45° FOV
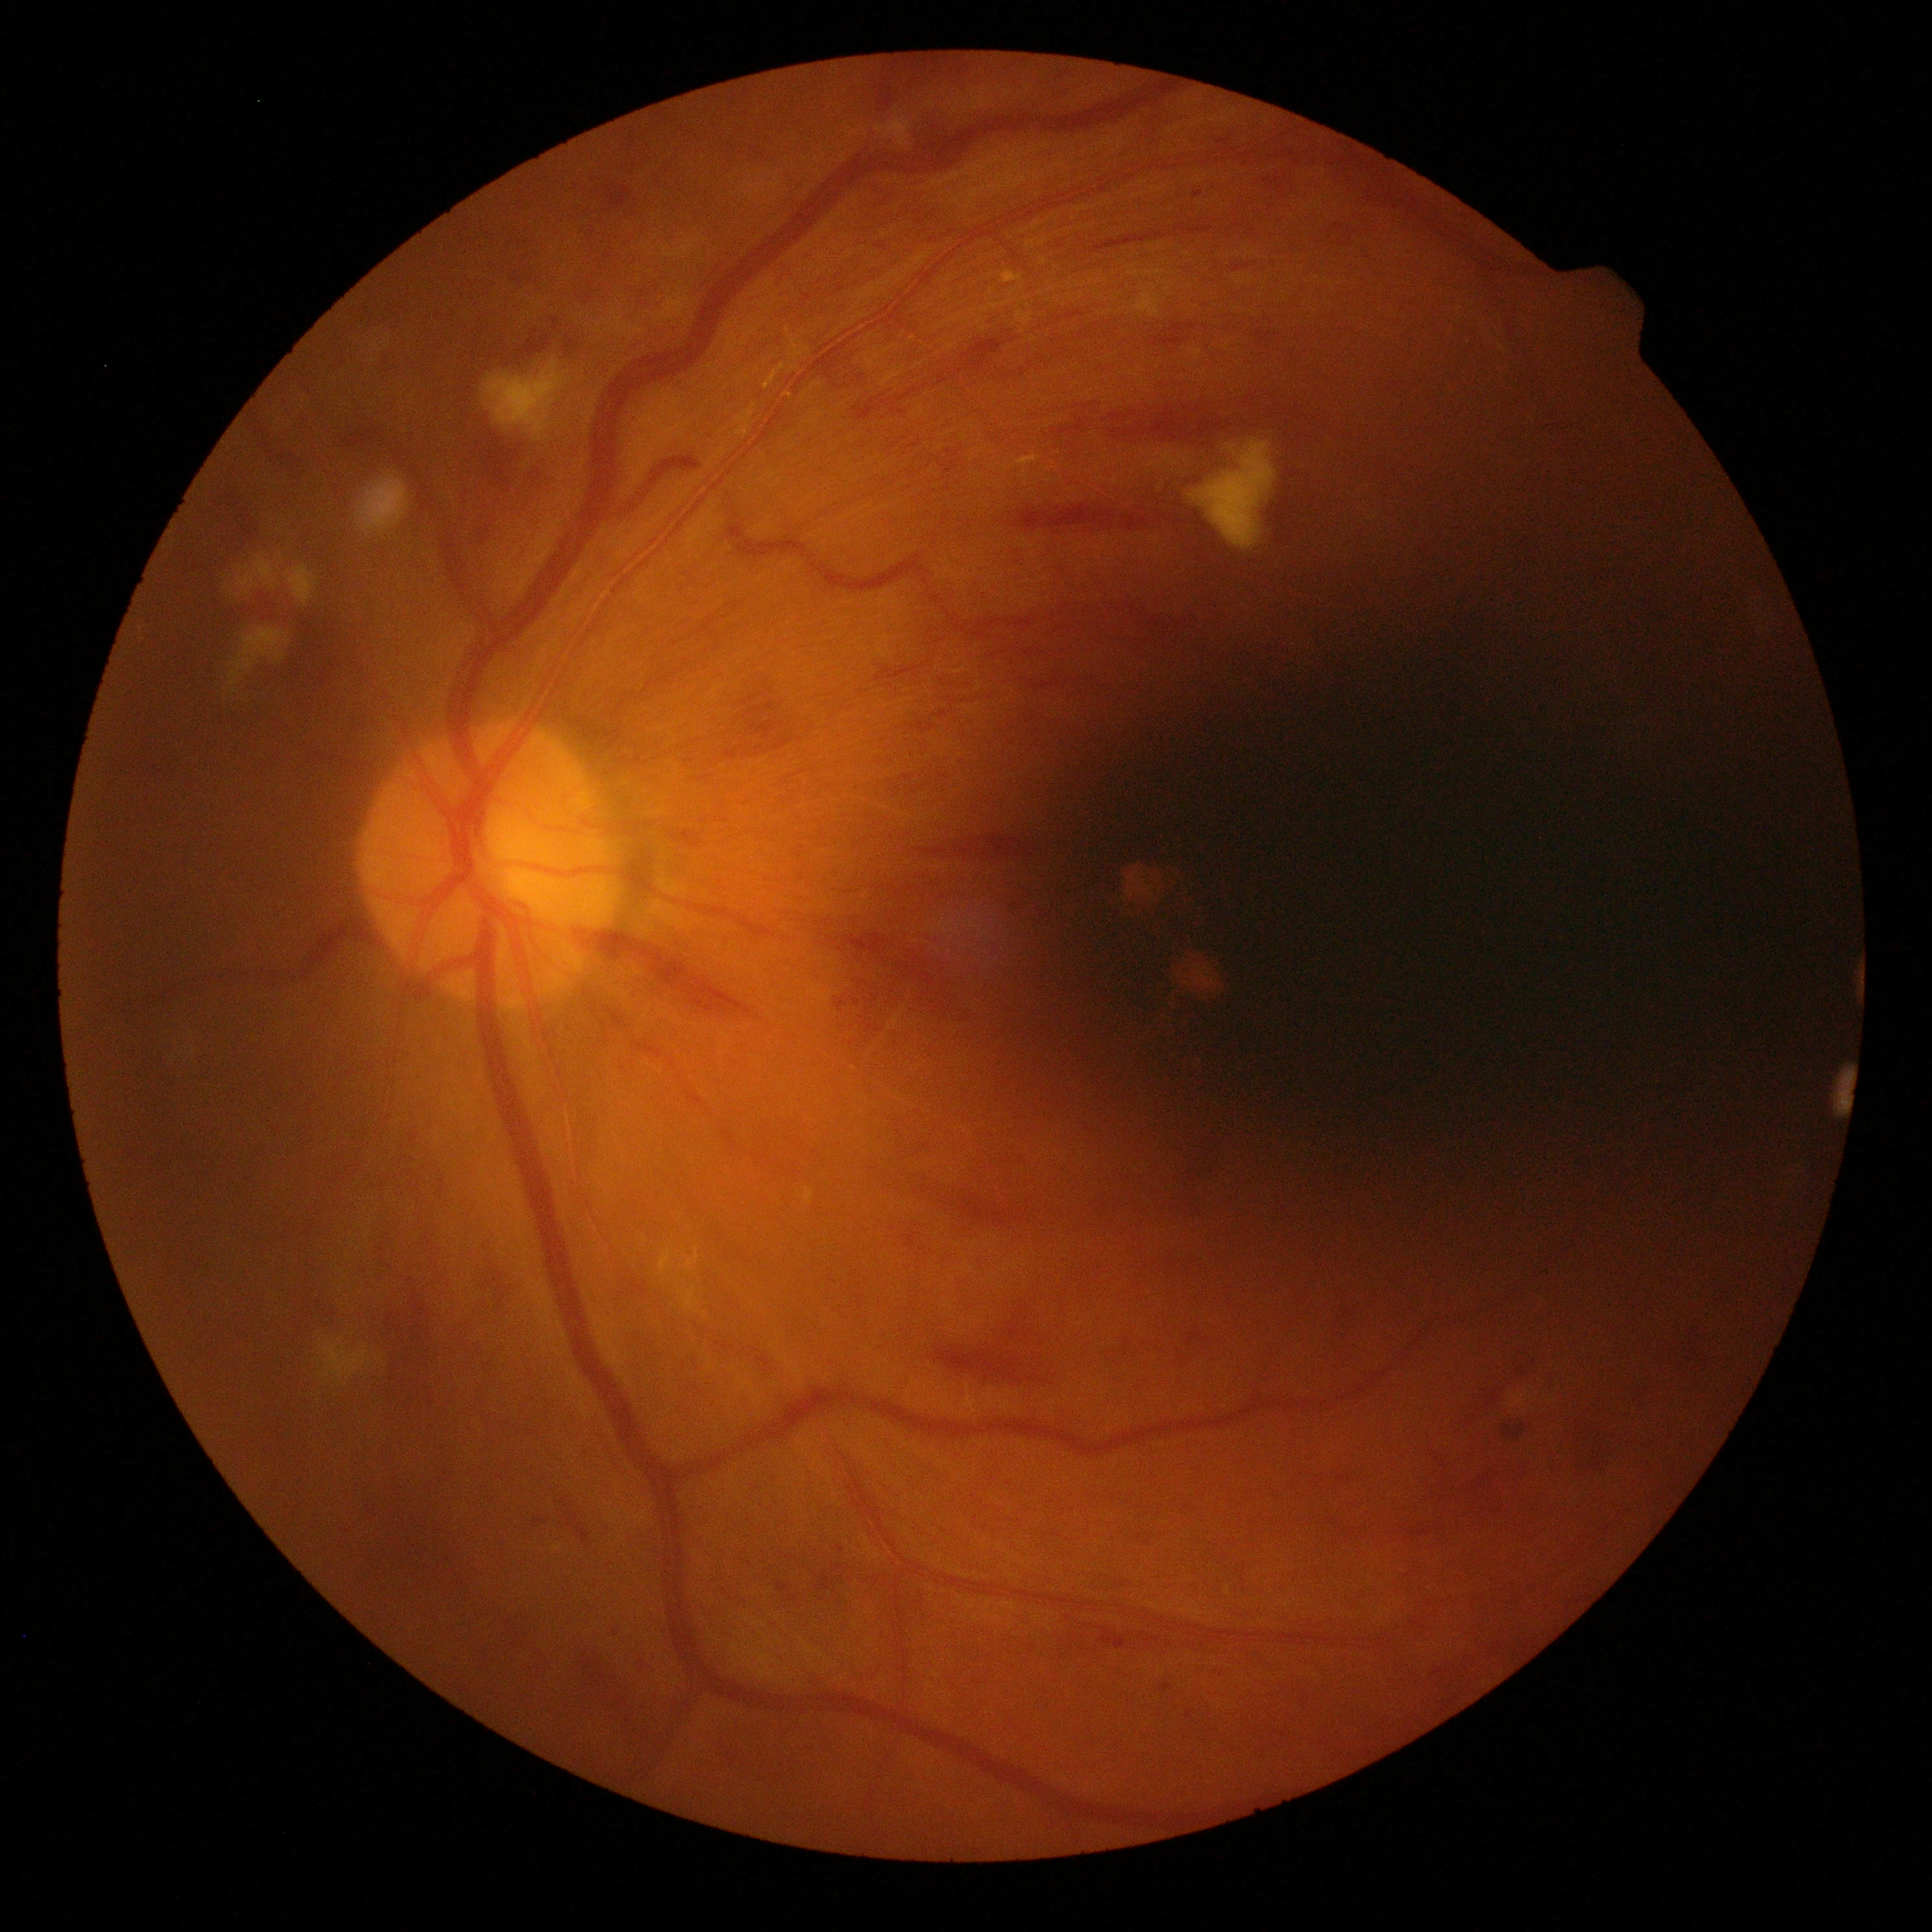 diabetic retinopathy grade=severe NPDR (3).